CFP, FOV: 45 degrees:
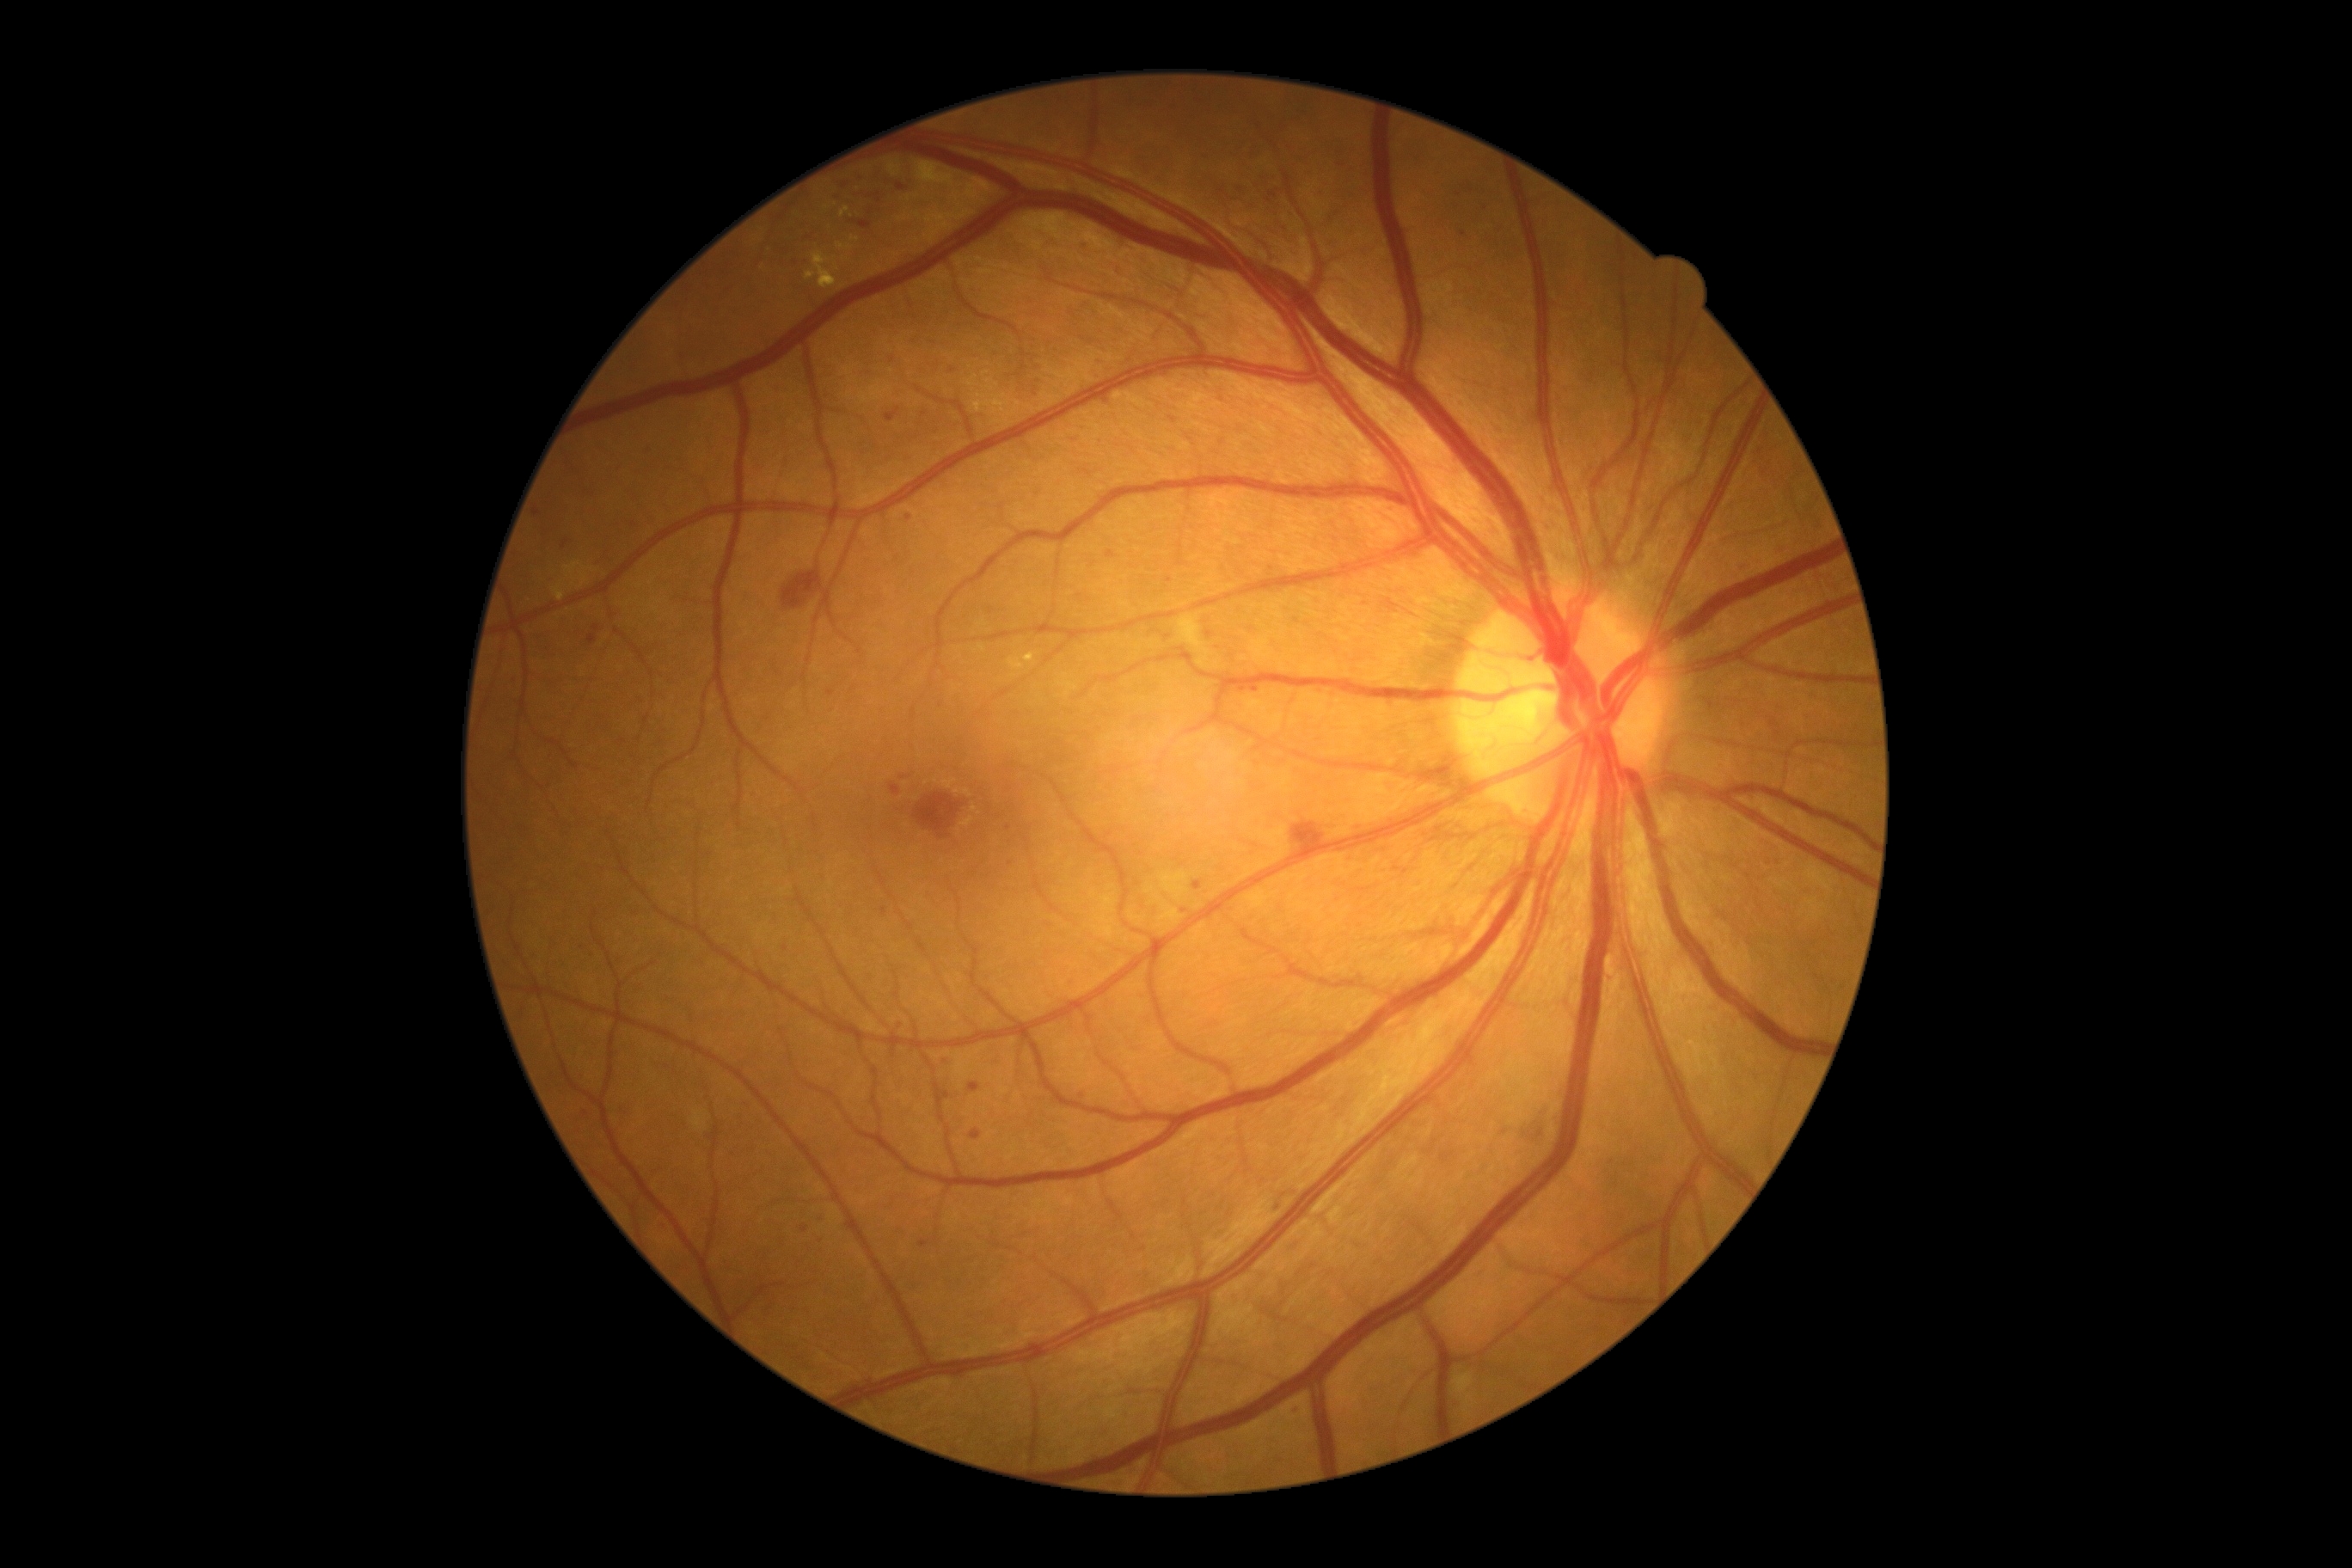
partial: true
dr_grade: 2
dr_grade_name: moderate NPDR
lesions:
  ma:
    - {"x1": 941, "y1": 1062, "x2": 953, "y2": 1070}
    - {"x1": 1086, "y1": 242, "x2": 1093, "y2": 252}
    - {"x1": 1253, "y1": 687, "x2": 1261, "y2": 694}
    - {"x1": 1032, "y1": 391, "x2": 1043, "y2": 400}
    - {"x1": 1739, "y1": 567, "x2": 1748, "y2": 575}
    - {"x1": 1251, "y1": 147, "x2": 1263, "y2": 161}
    - {"x1": 886, "y1": 408, "x2": 900, "y2": 422}
    - {"x1": 534, "y1": 510, "x2": 541, "y2": 518}
  ma_small_centers:
    - <pt>900,187</pt>
    - <pt>533,958</pt>
    - <pt>1173,420</pt>
    - <pt>1779,553</pt>
    - <pt>1773,723</pt>
    - <pt>839,198</pt>
    - <pt>831,693</pt>
    - <pt>900,1027</pt>
    - <pt>925,415</pt>